Wide-field contact fundus photograph of an infant: 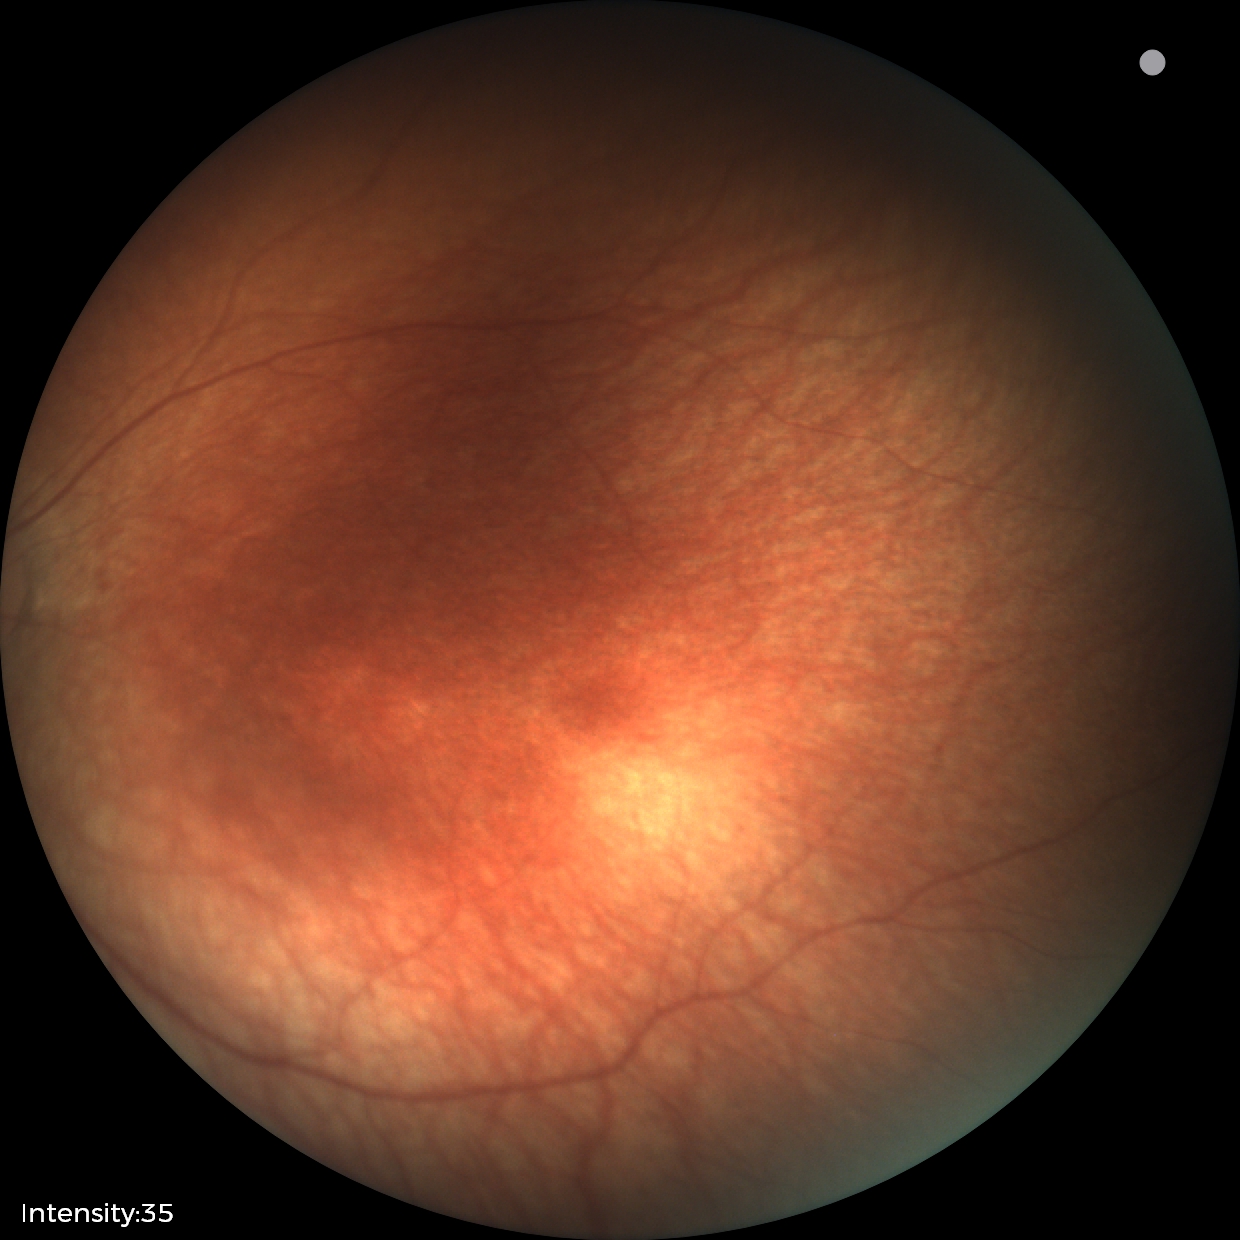

Screening examination diagnosed as physiological.